Portable fundus camera image. 2212 by 1659 pixels. FOV: 60 degrees.
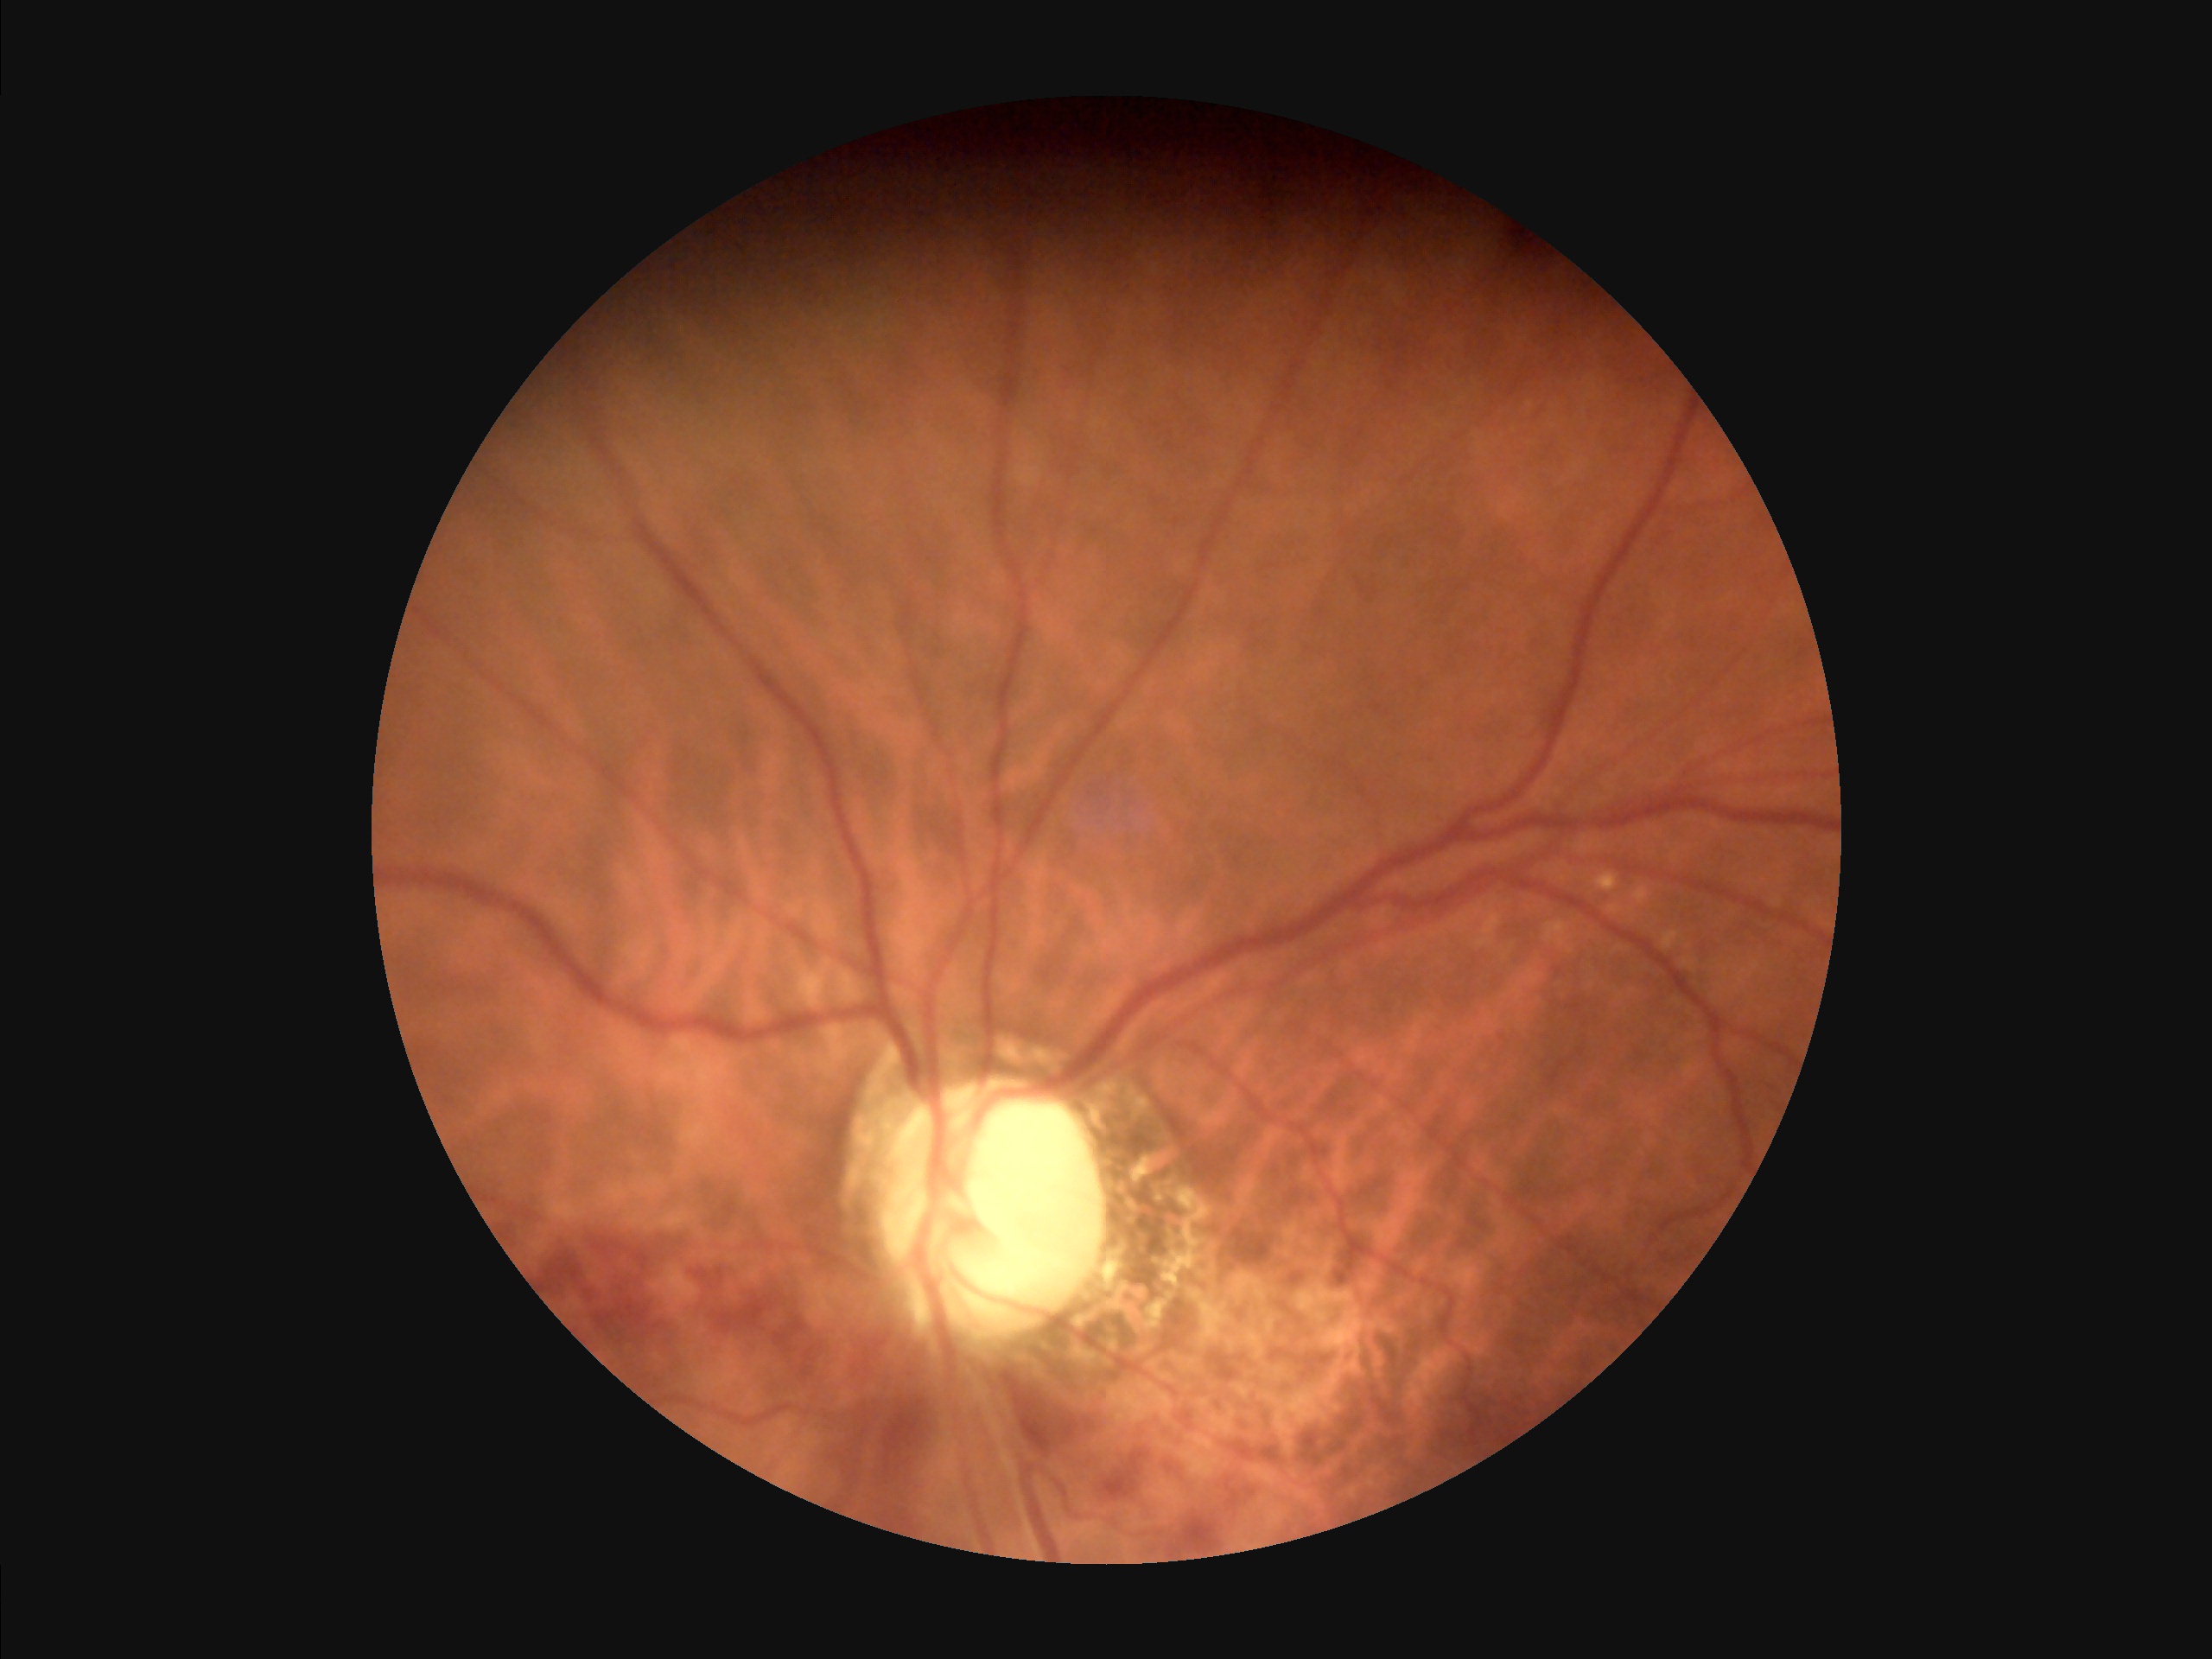

Illumination and color balance are good.
Overall quality is good and the image is gradable.
Optic disc, vessels, and background are in focus.
Vessels and details are readily distinguishable.